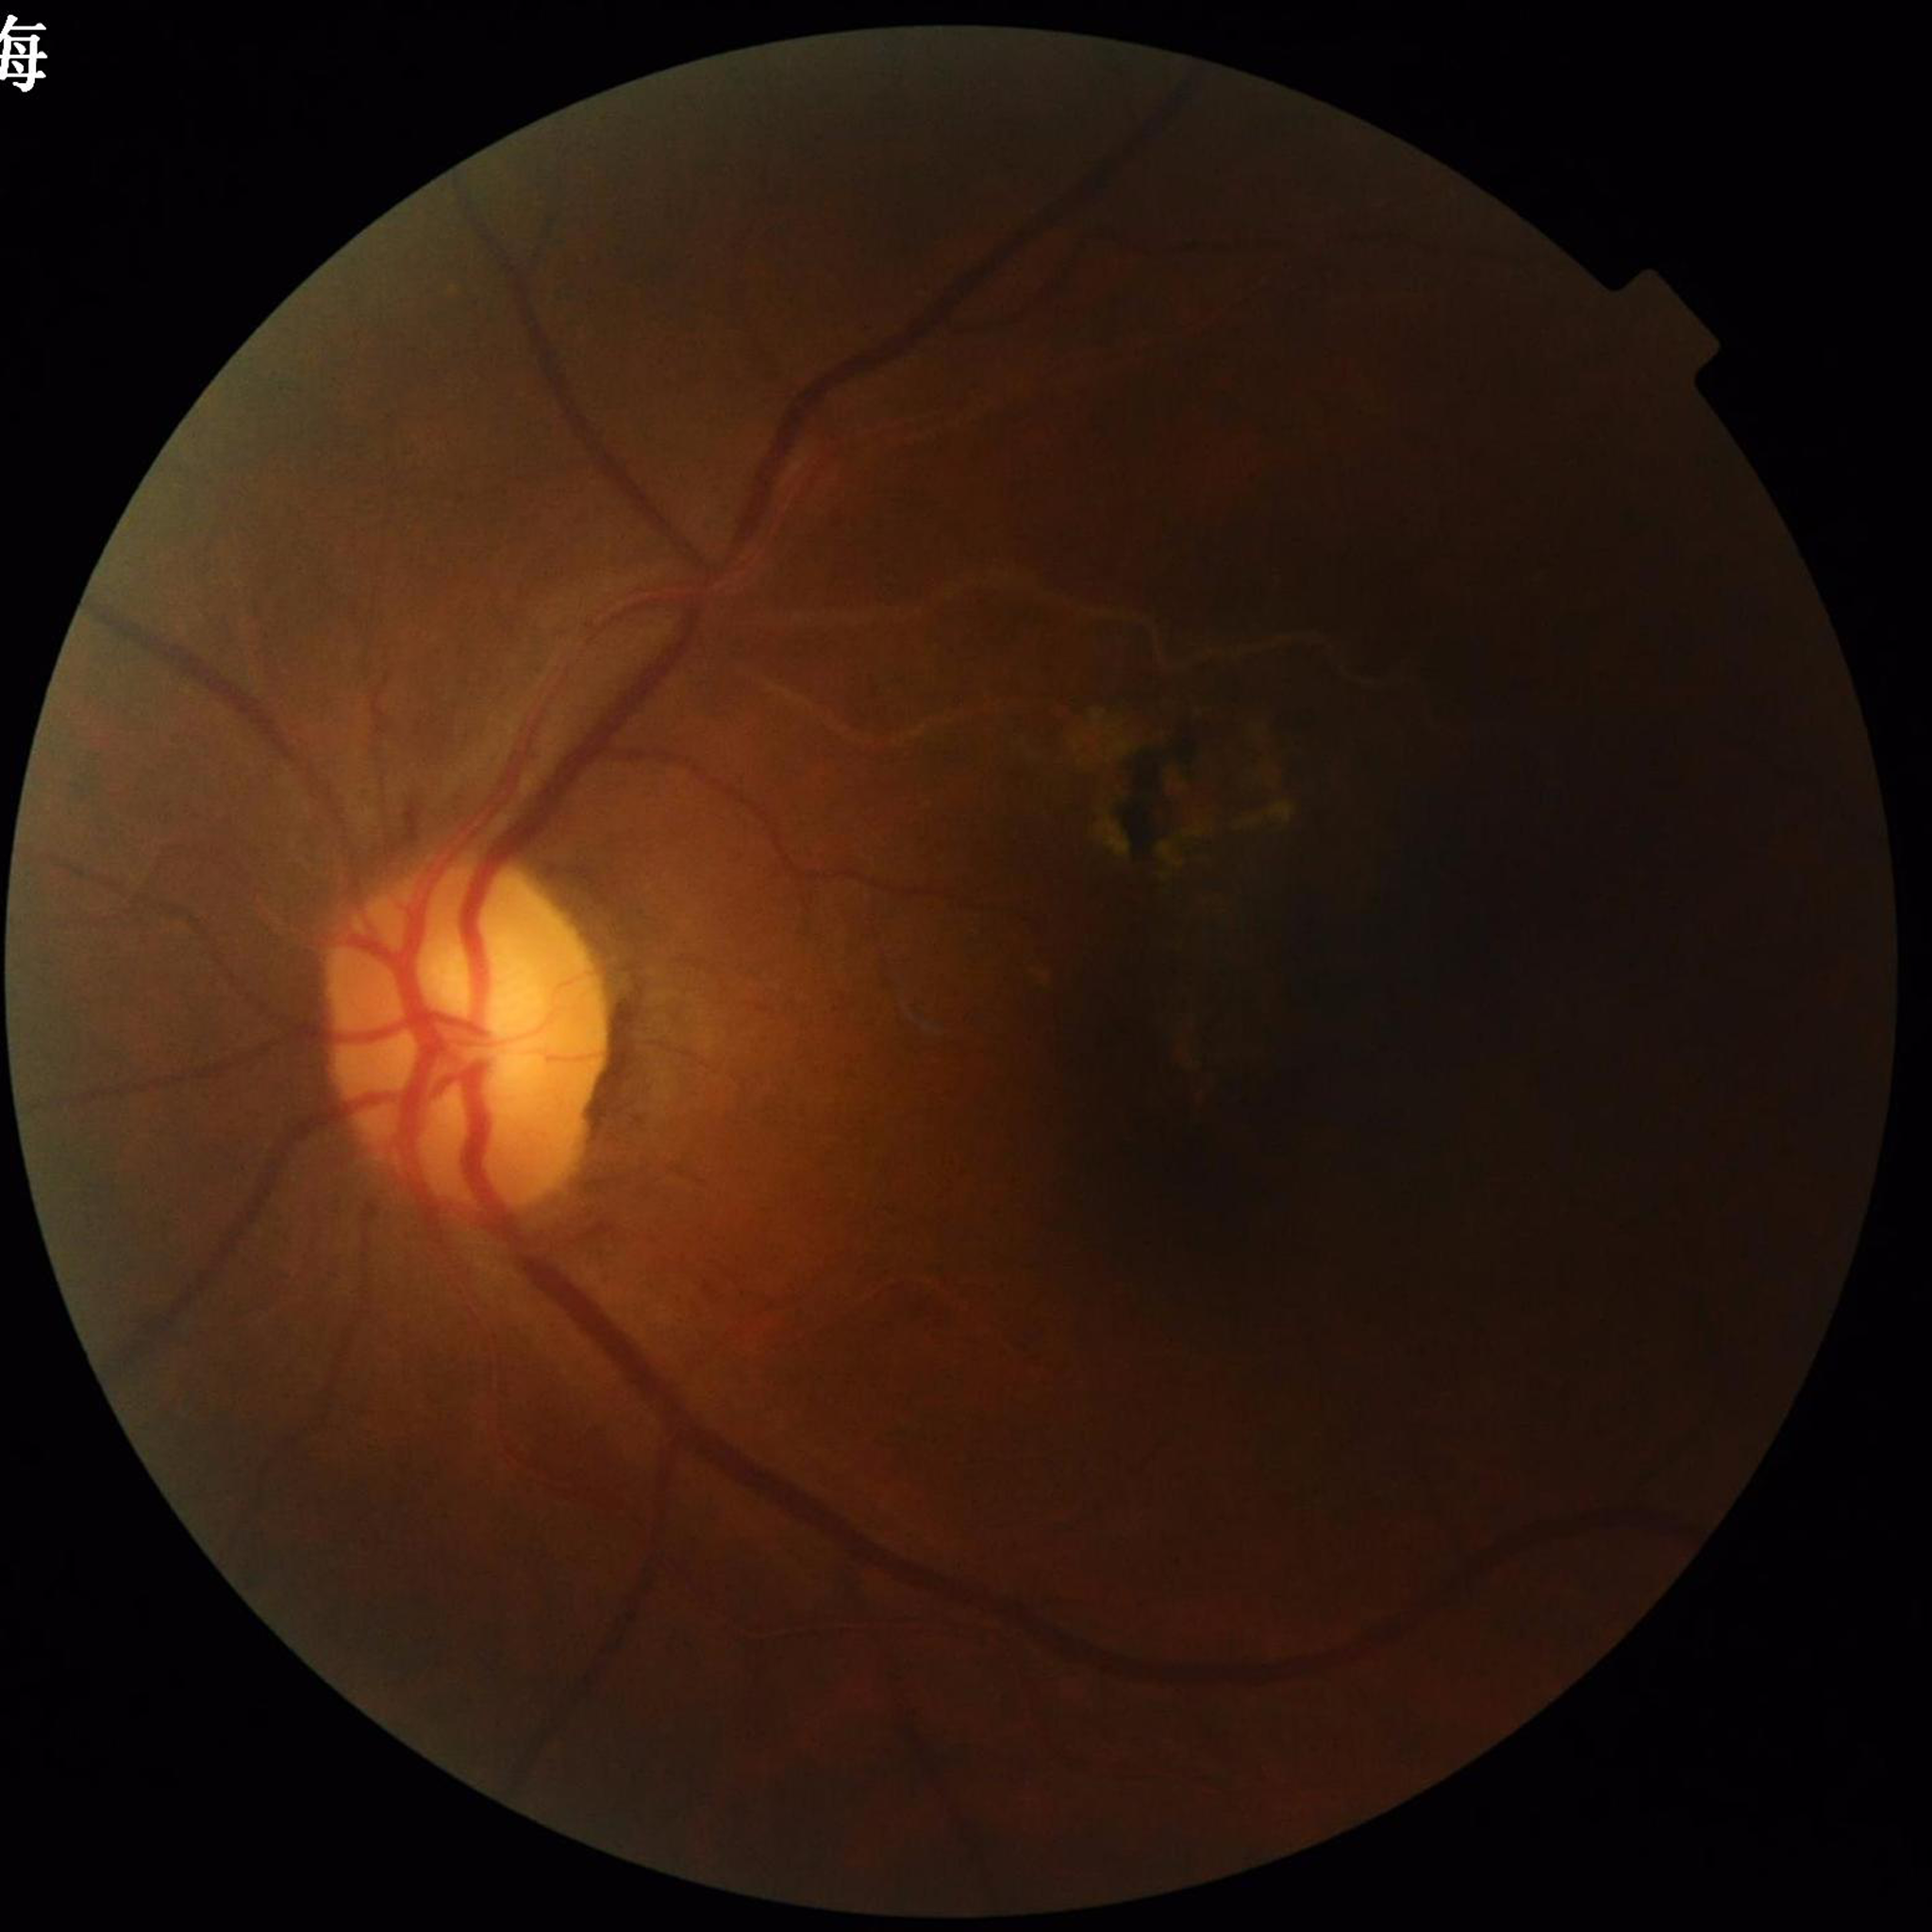

Automated quality assessment: concerns include illumination/color distortion, blur | Clinical diagnosis: glaucoma.